Retinal fundus photograph, NIDEK AFC-230 fundus camera: 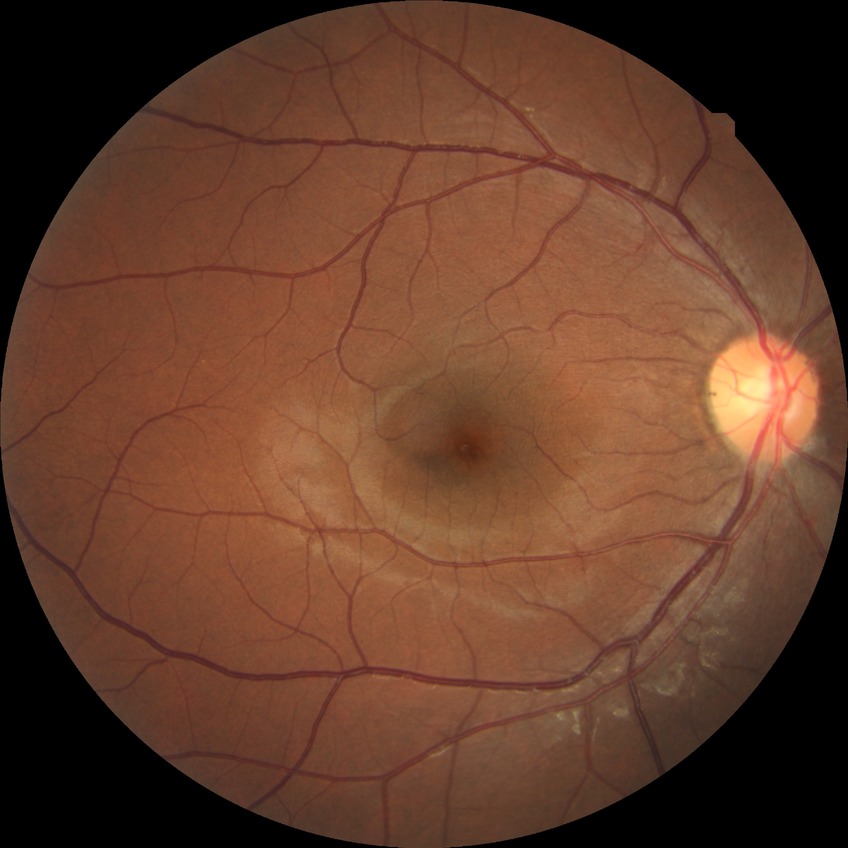
Modified Davis classification is no diabetic retinopathy.